Davis DR grading:
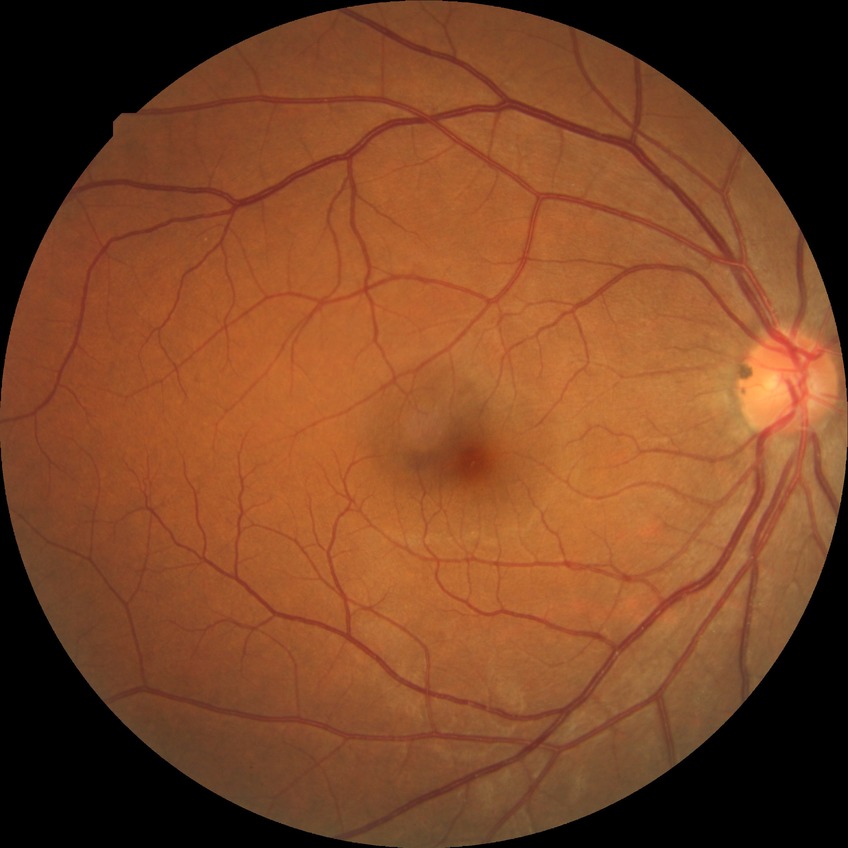
Diabetic retinopathy (DR) is NDR (no diabetic retinopathy).